Camera: Natus RetCam Envision (130° FOV). RetCam wide-field infant fundus image
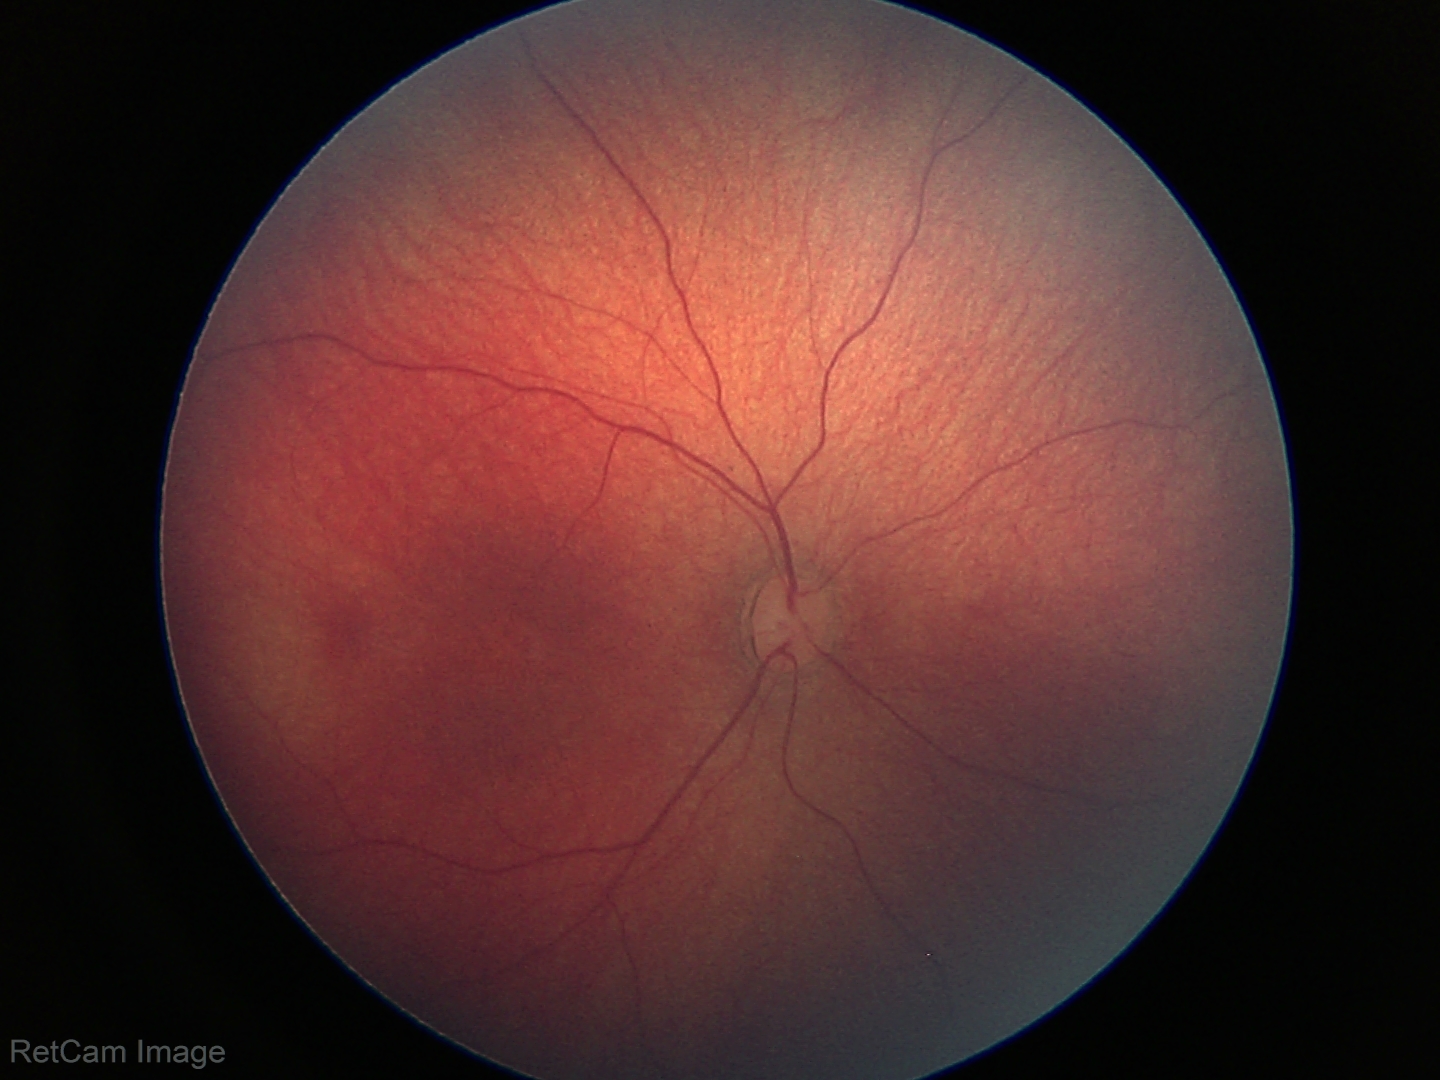 Physiological retinal appearance for postconceptual age.